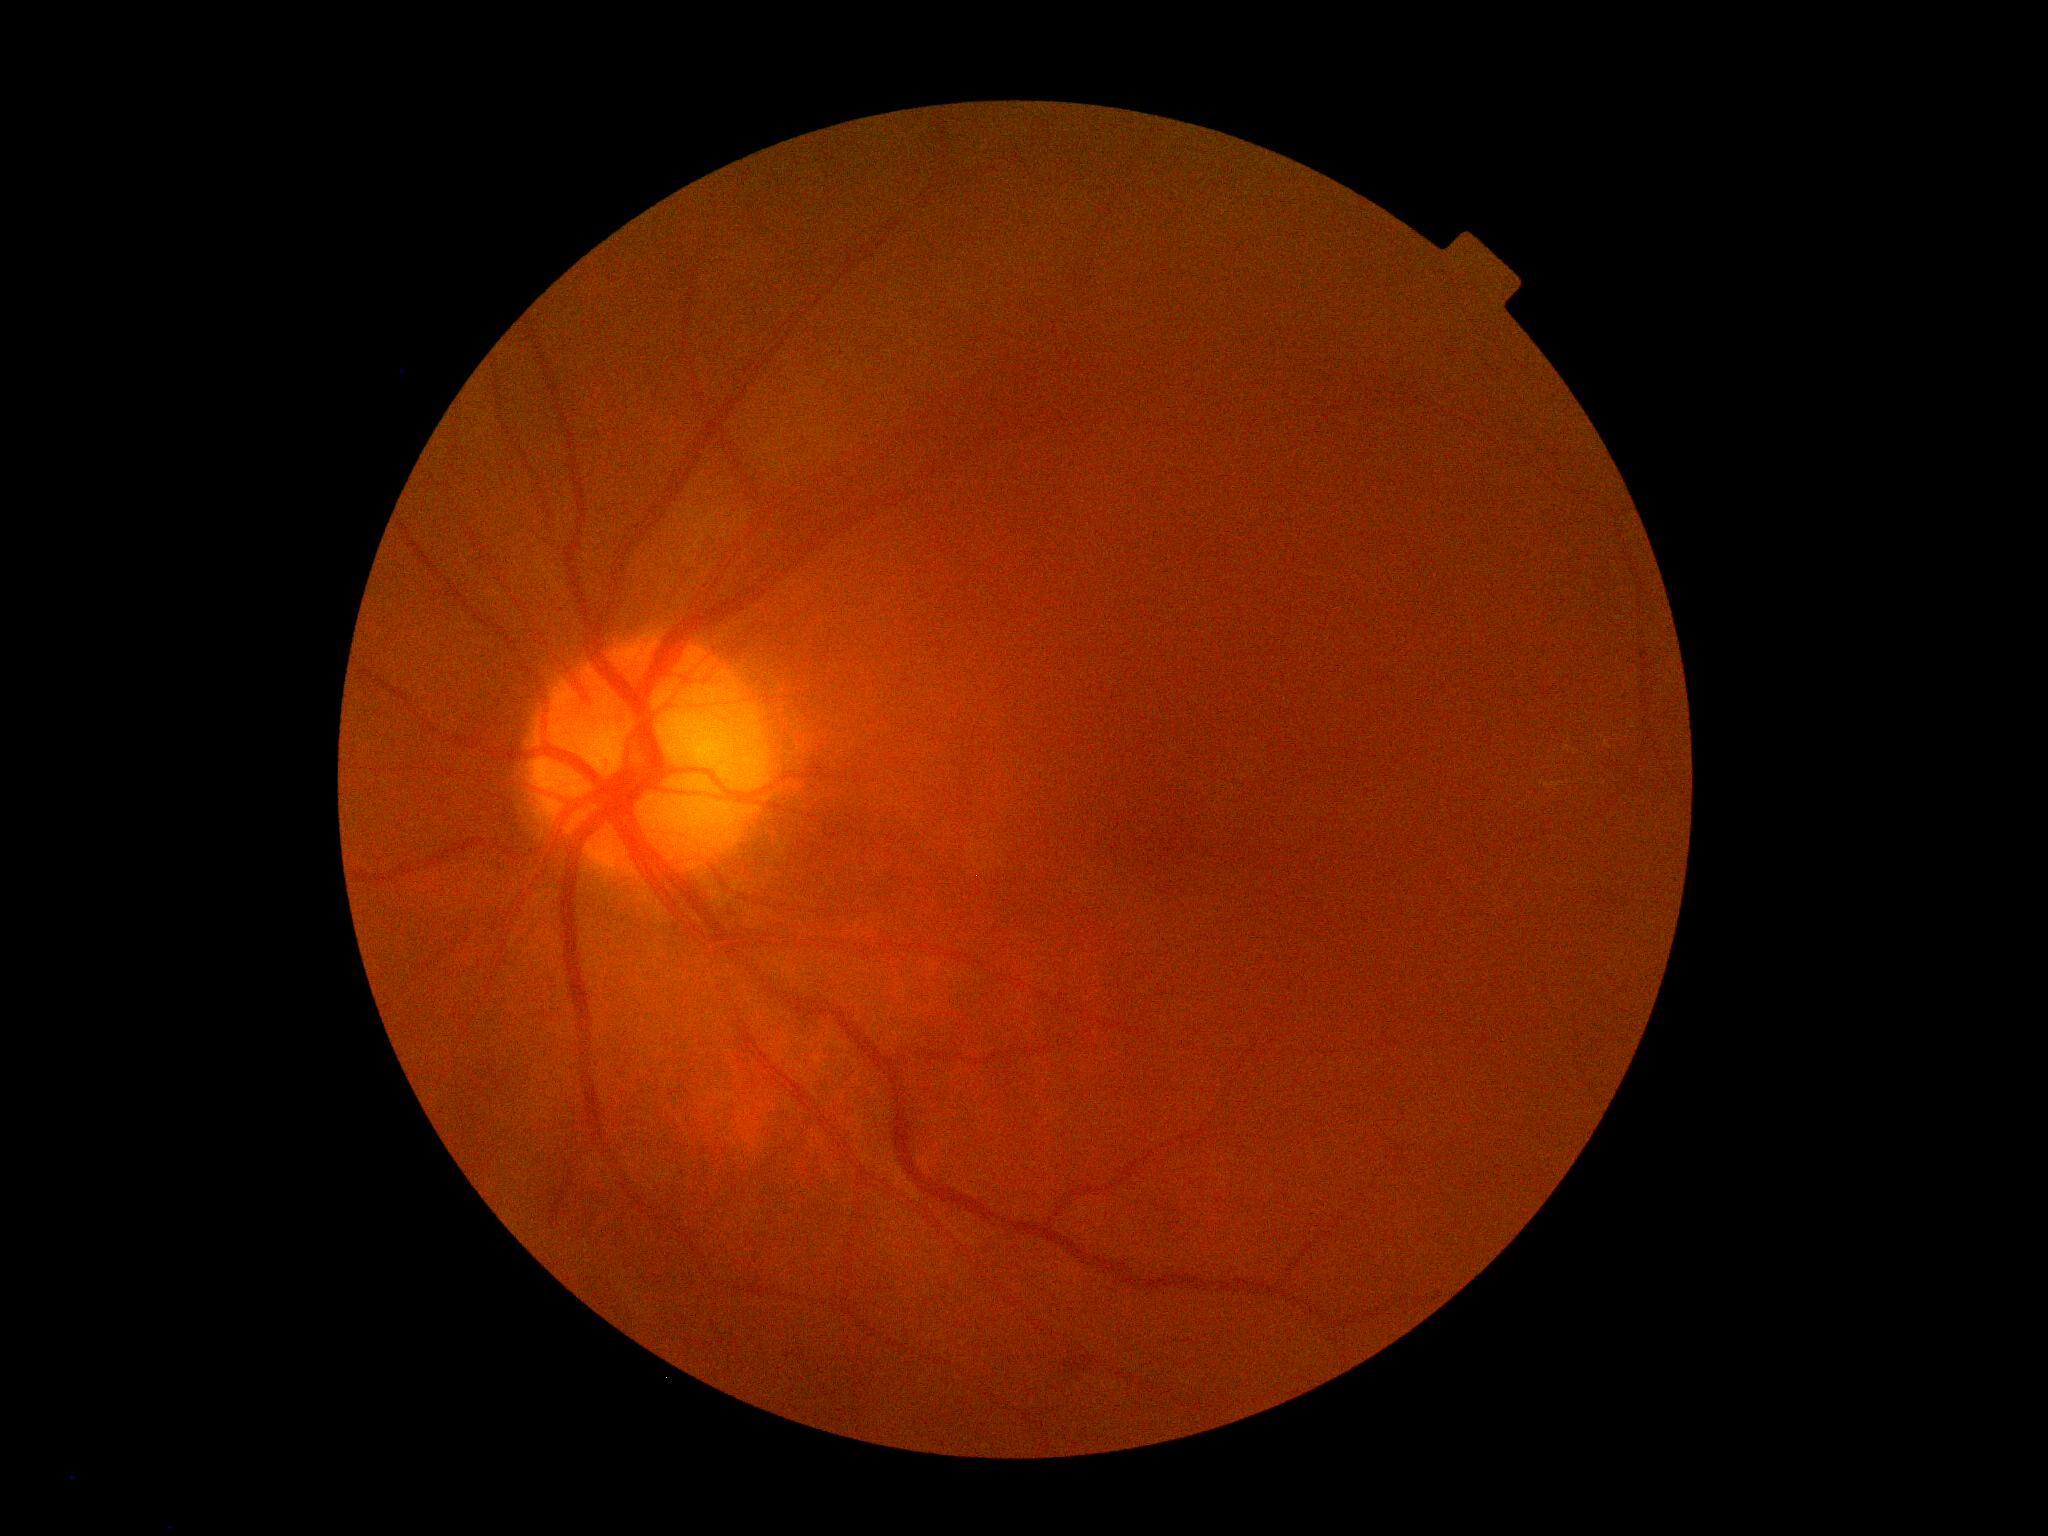

Diabetic retinopathy (DR): grade 2 (moderate NPDR).
DR class: non-proliferative diabetic retinopathy.